45° FOV; image size 2048x1536; retinal fundus photograph:
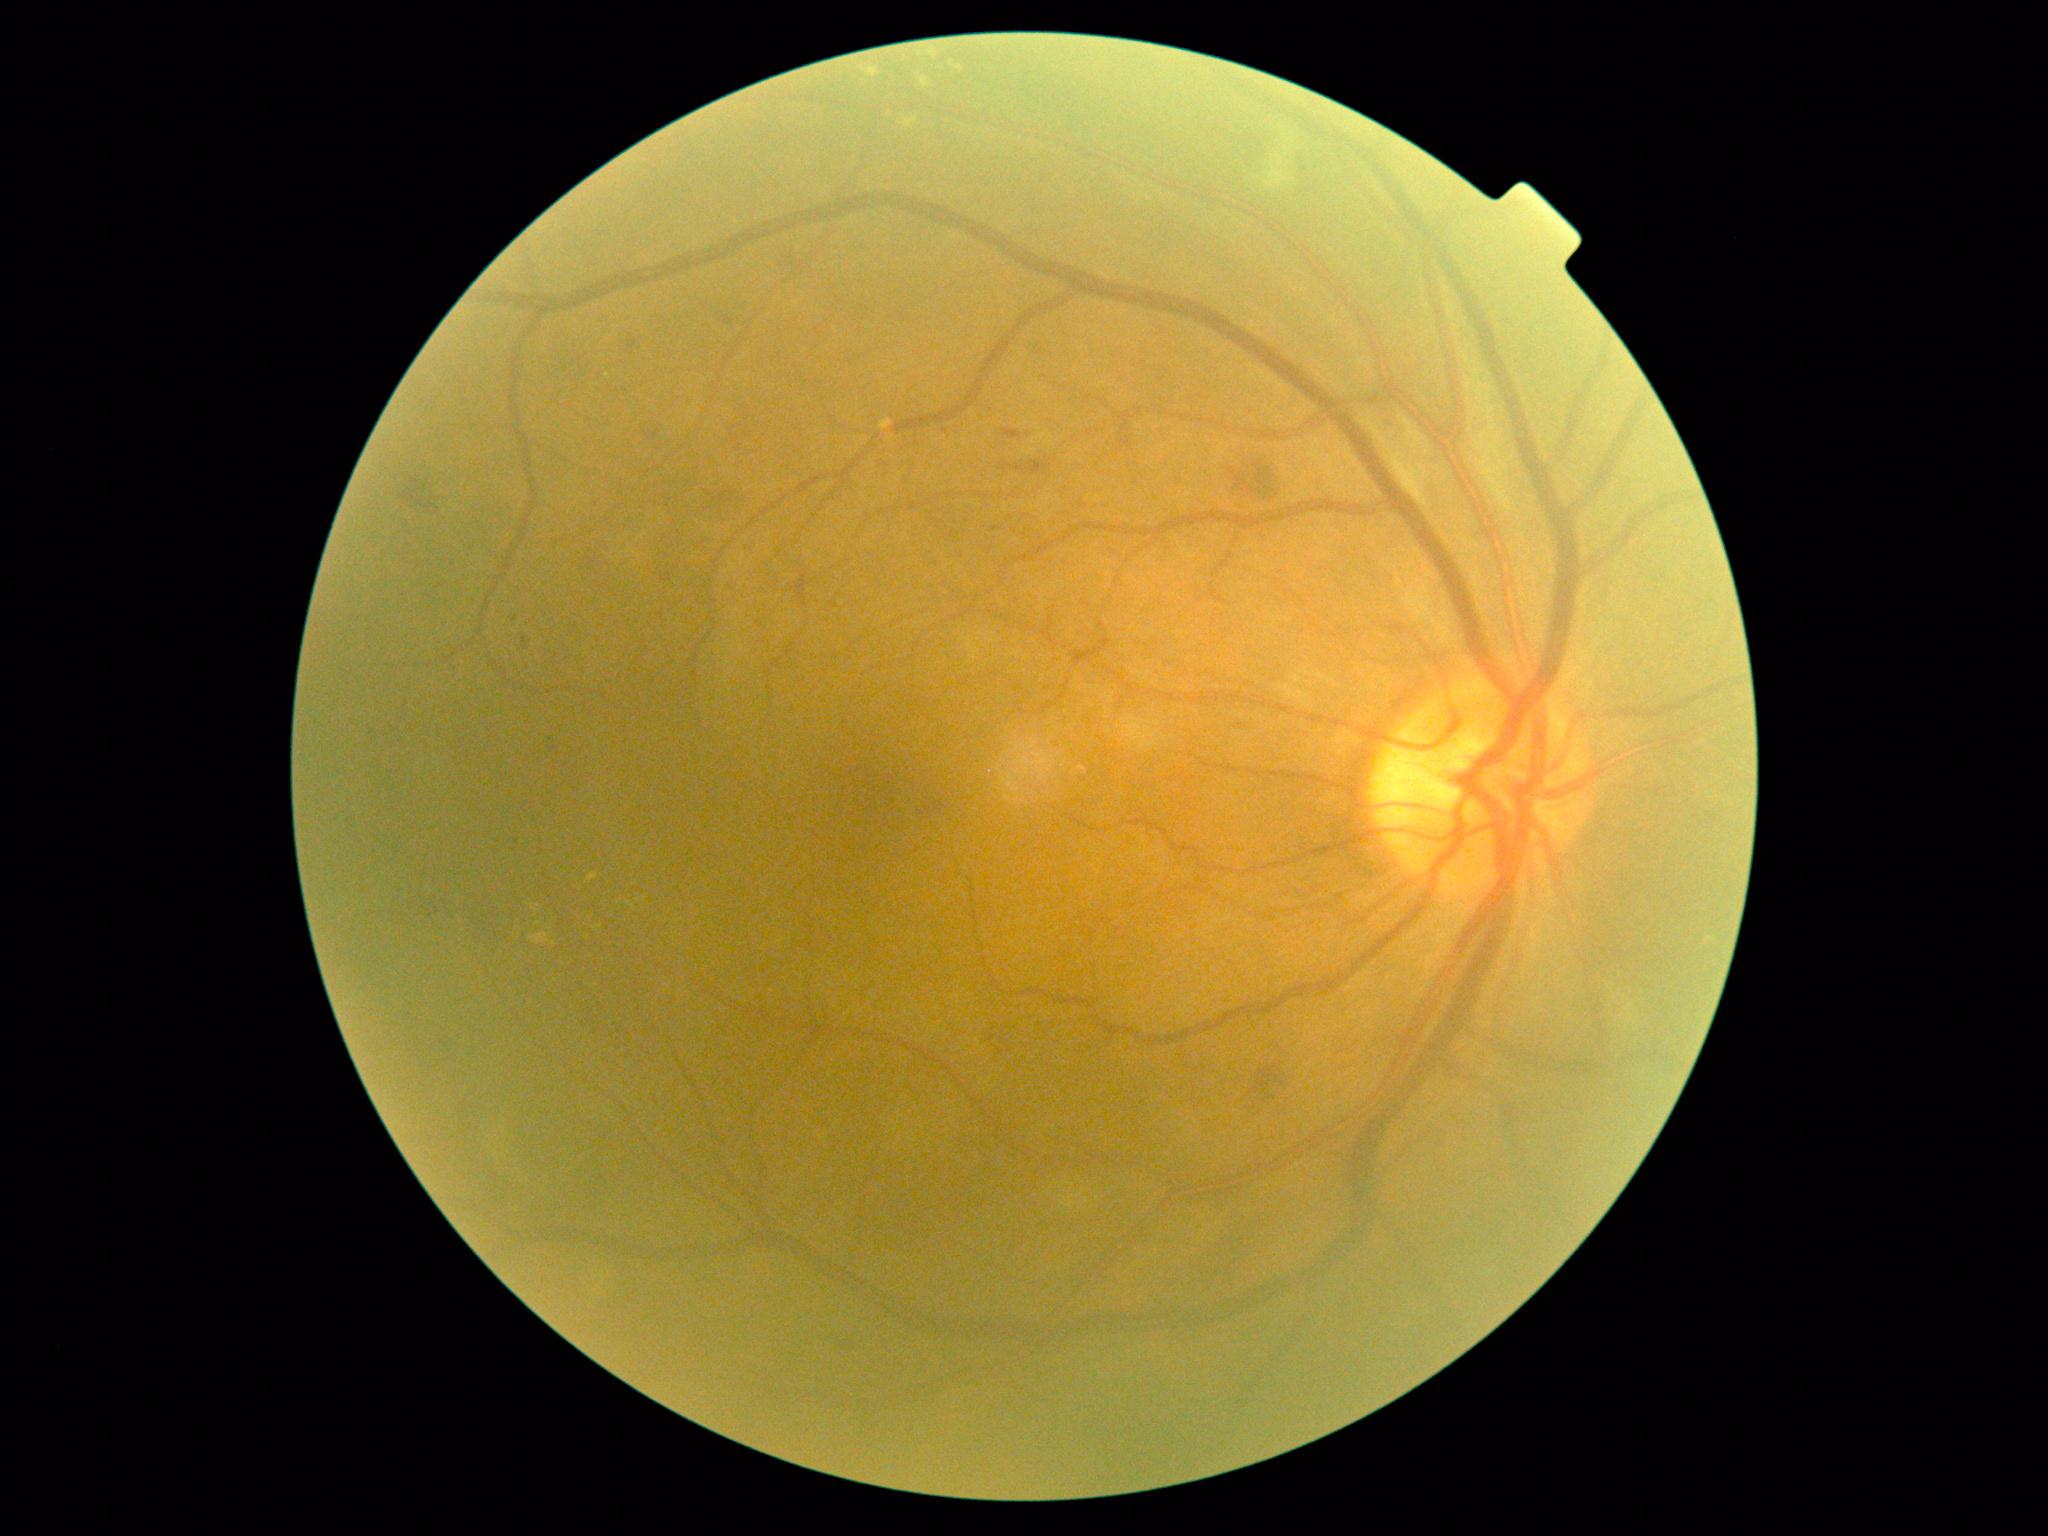 Diabetic retinopathy is 2/4 — more than just microaneurysms but less than severe NPDR.